Image size 2352x1568
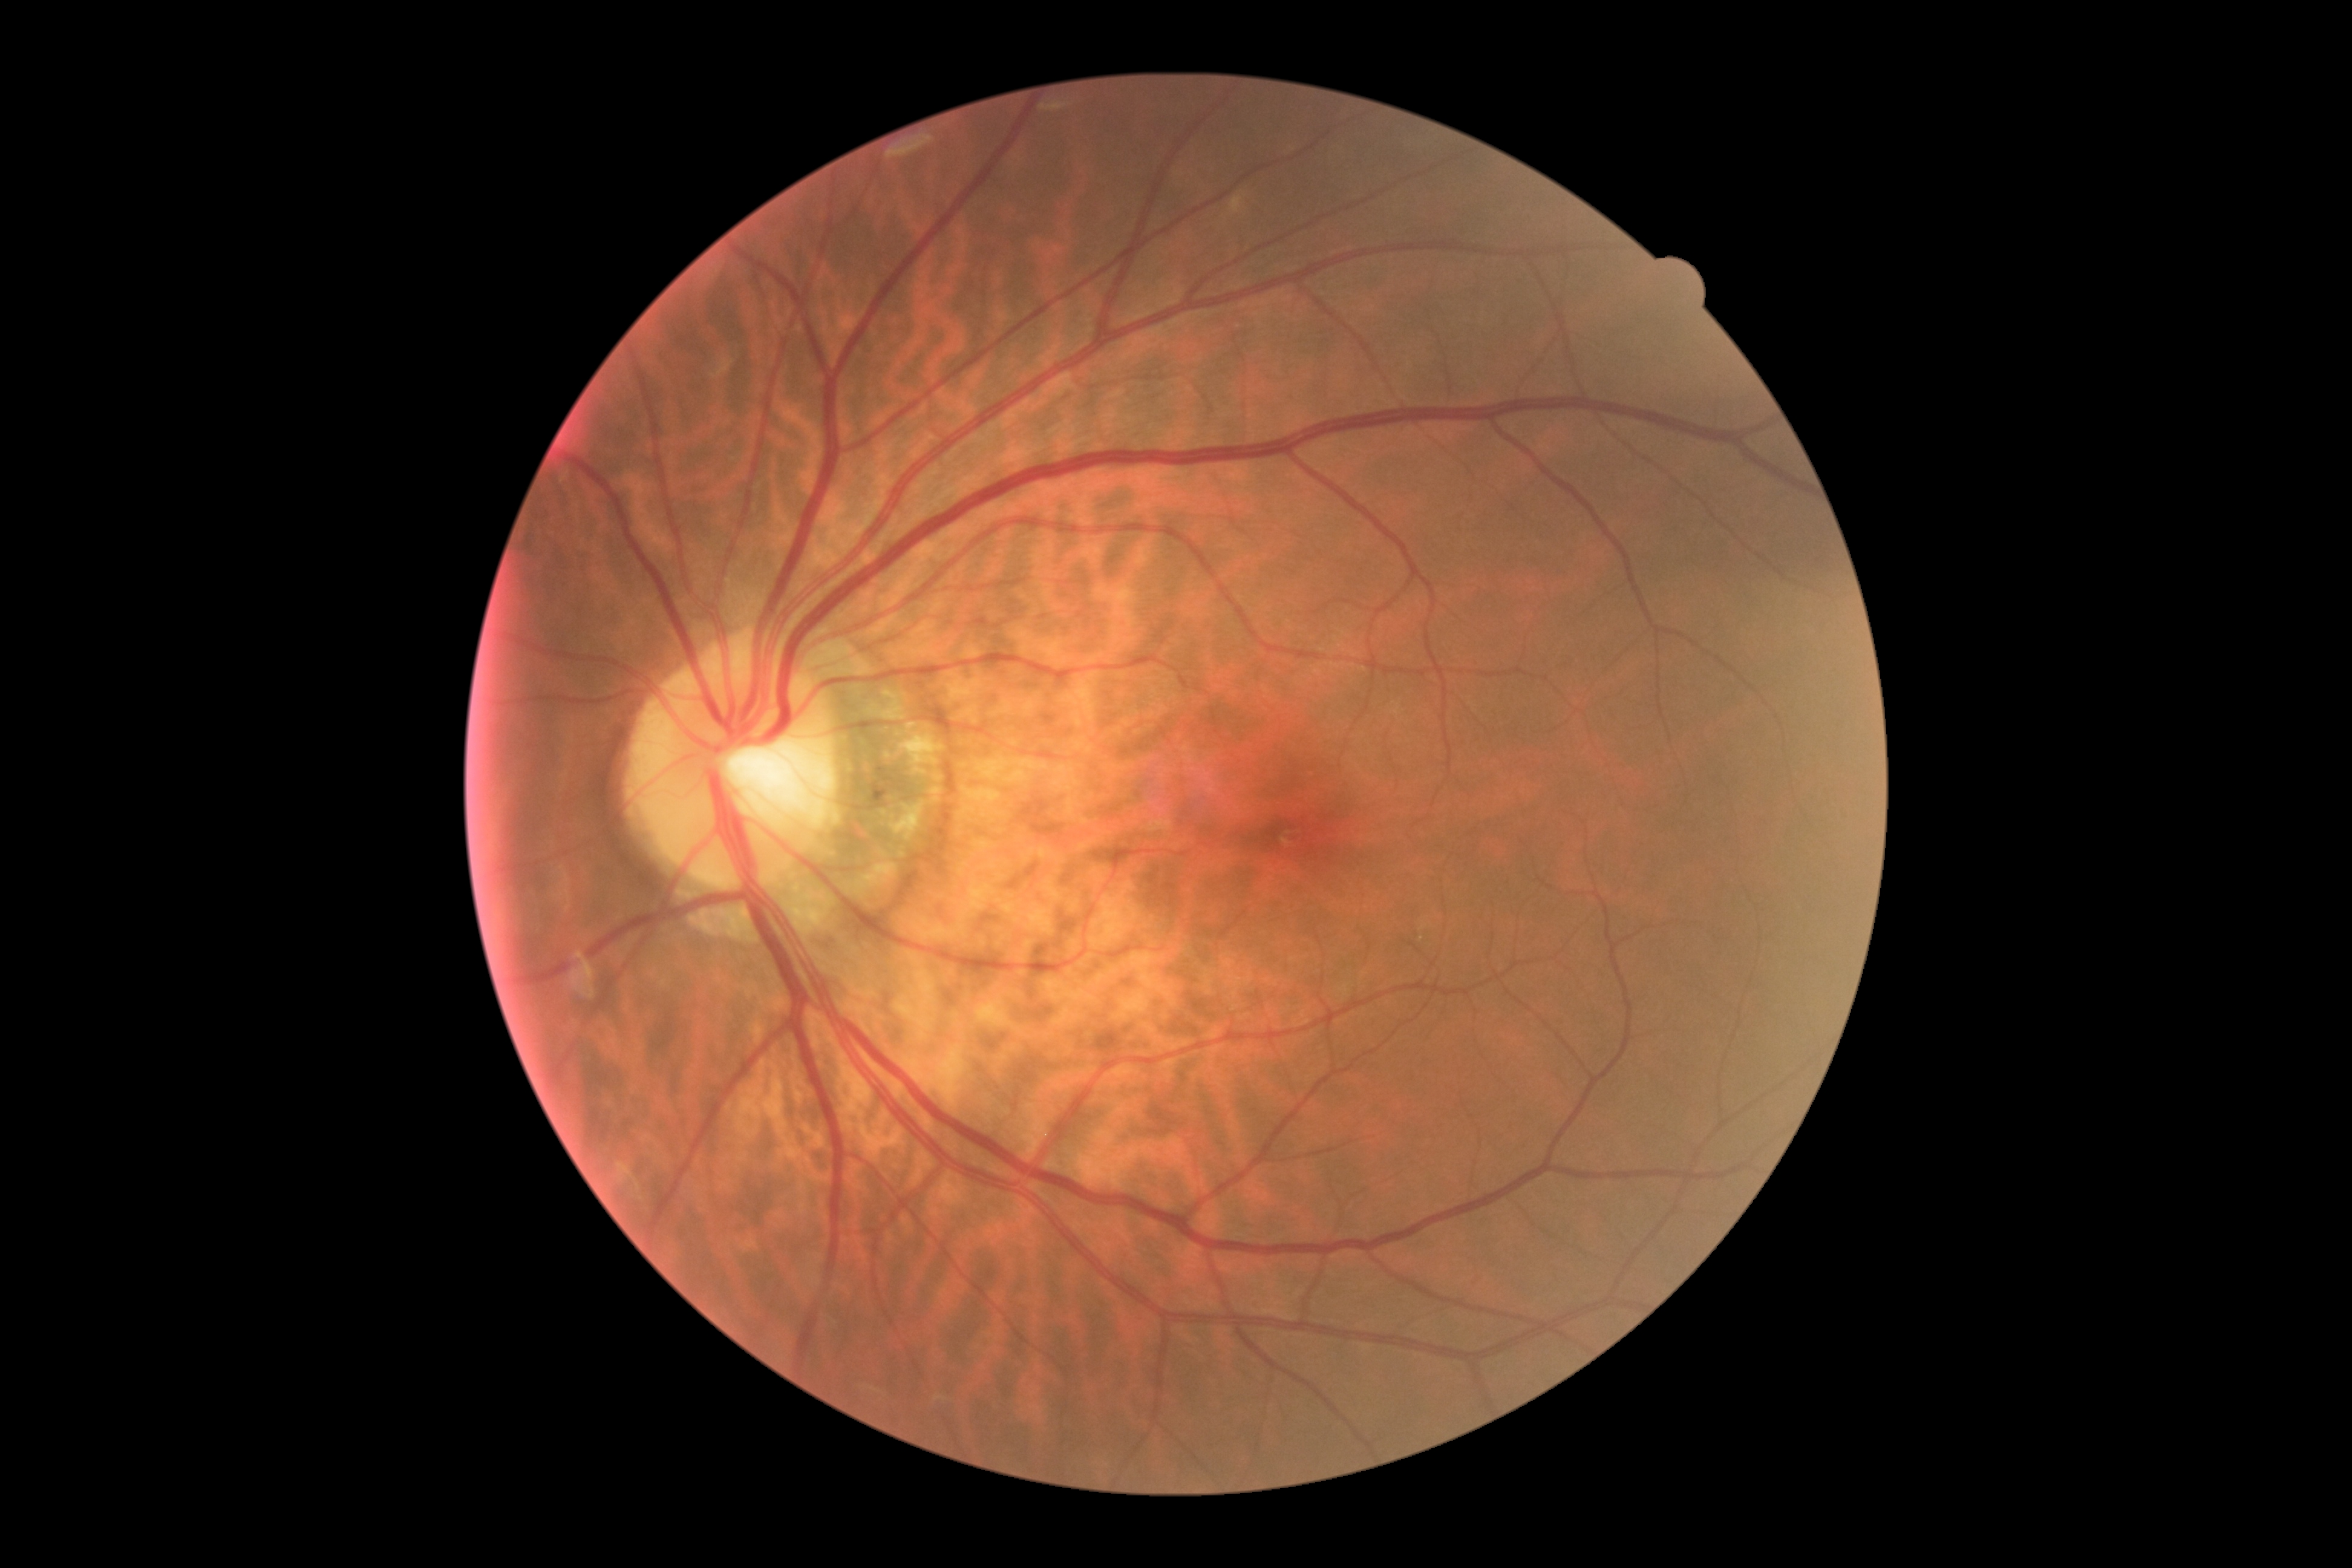

{
  "dr_grade": "grade 0"
}